Without pupil dilation · 45° FOV · camera: NIDEK AFC-230 · 848x848 · color fundus photograph: 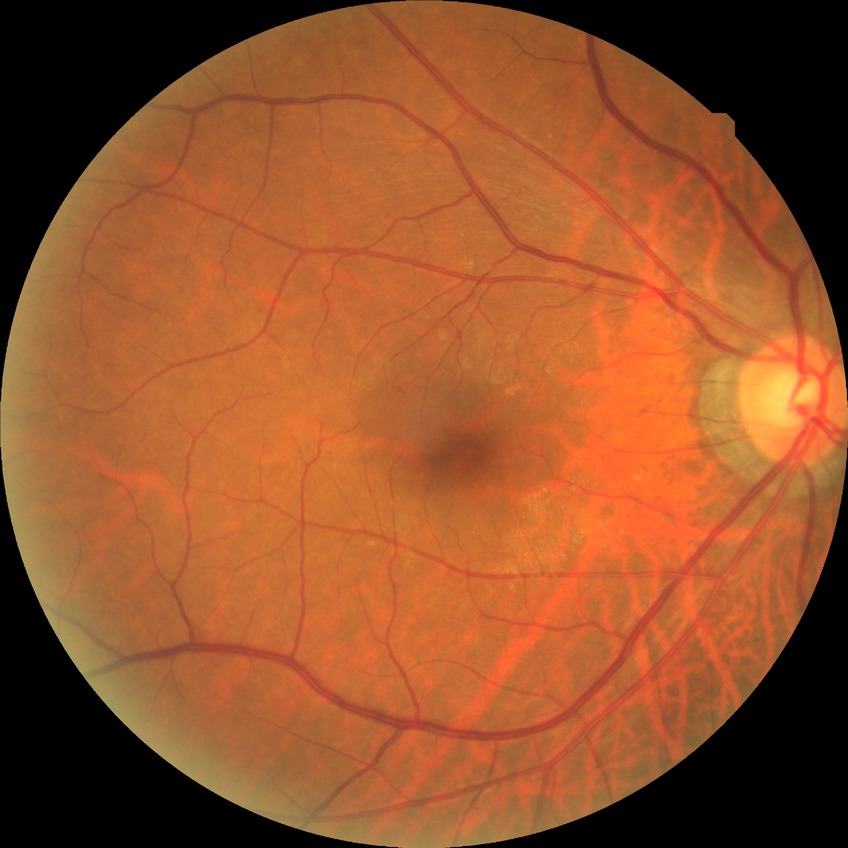 modified Davis classification=no diabetic retinopathy.